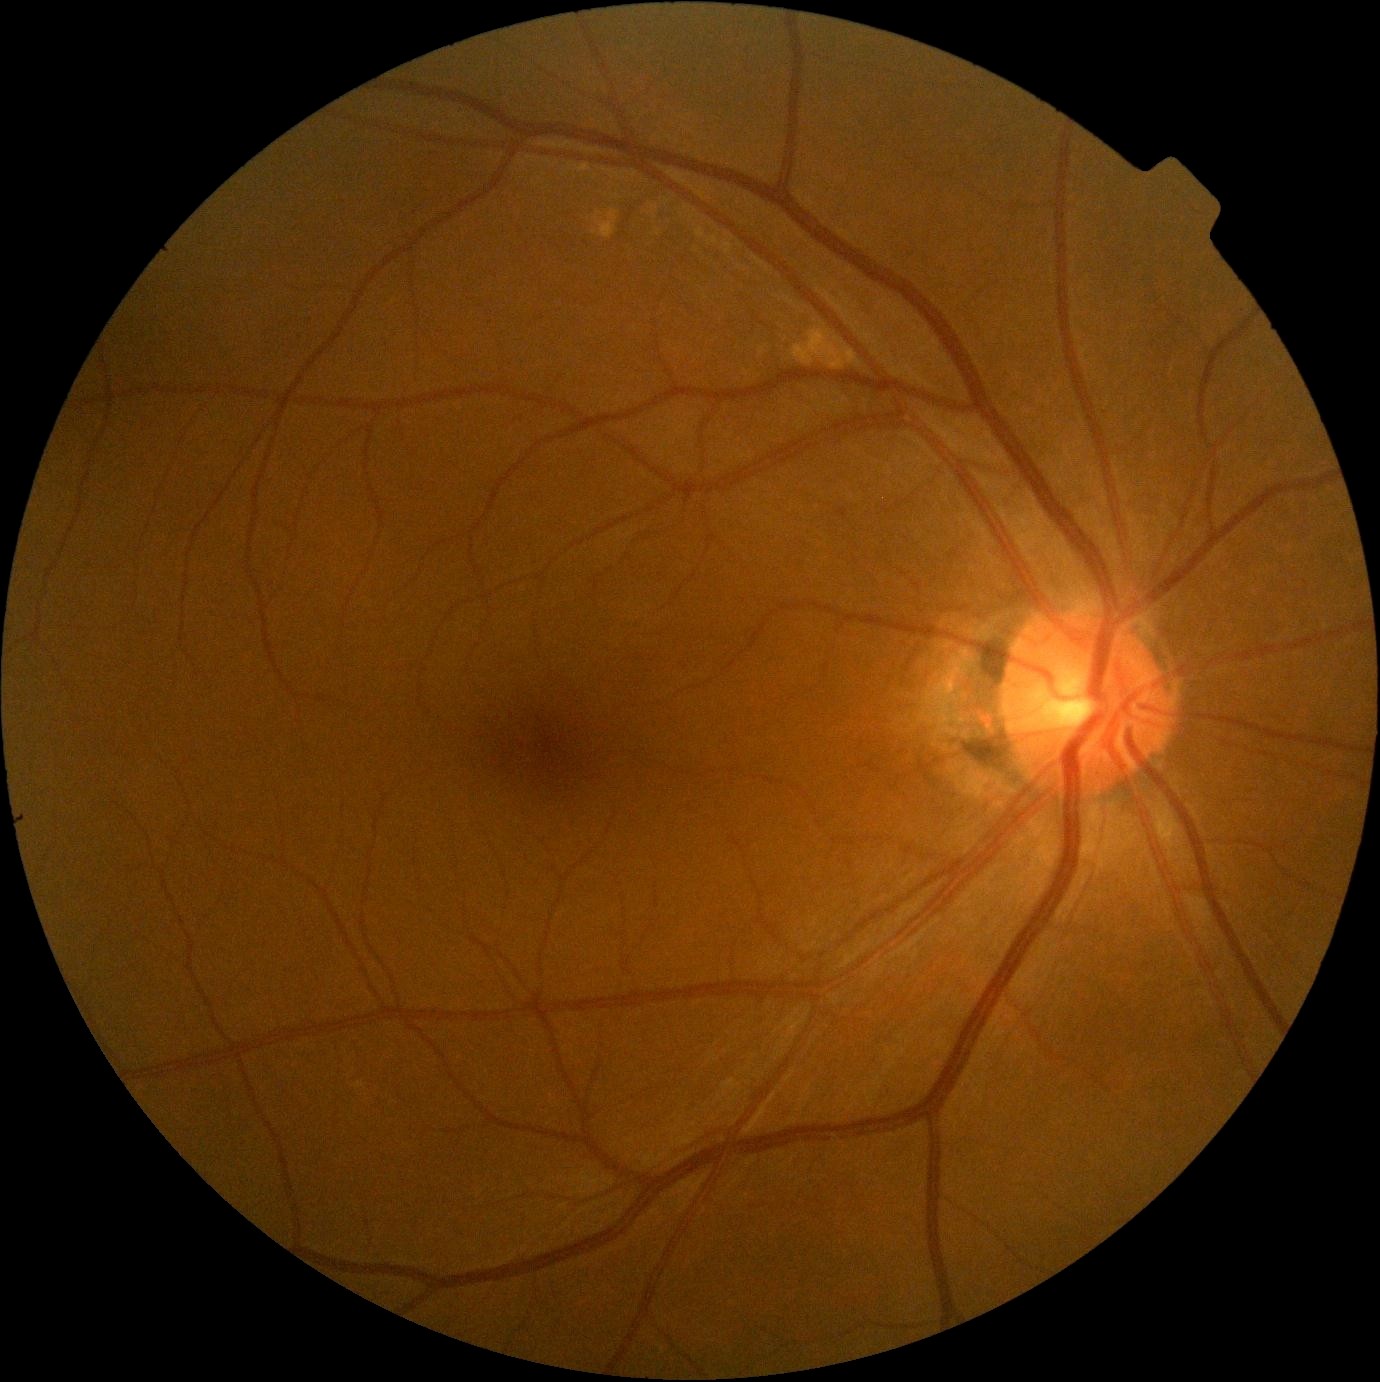
No signs of diabetic retinopathy. Retinopathy: grade 0.